Non-mydriatic · pachymetry 555 µm · centered on the optic disc · captured on a Topcon TRC-NW400 fundus camera · 2212 x 1661 pixels: 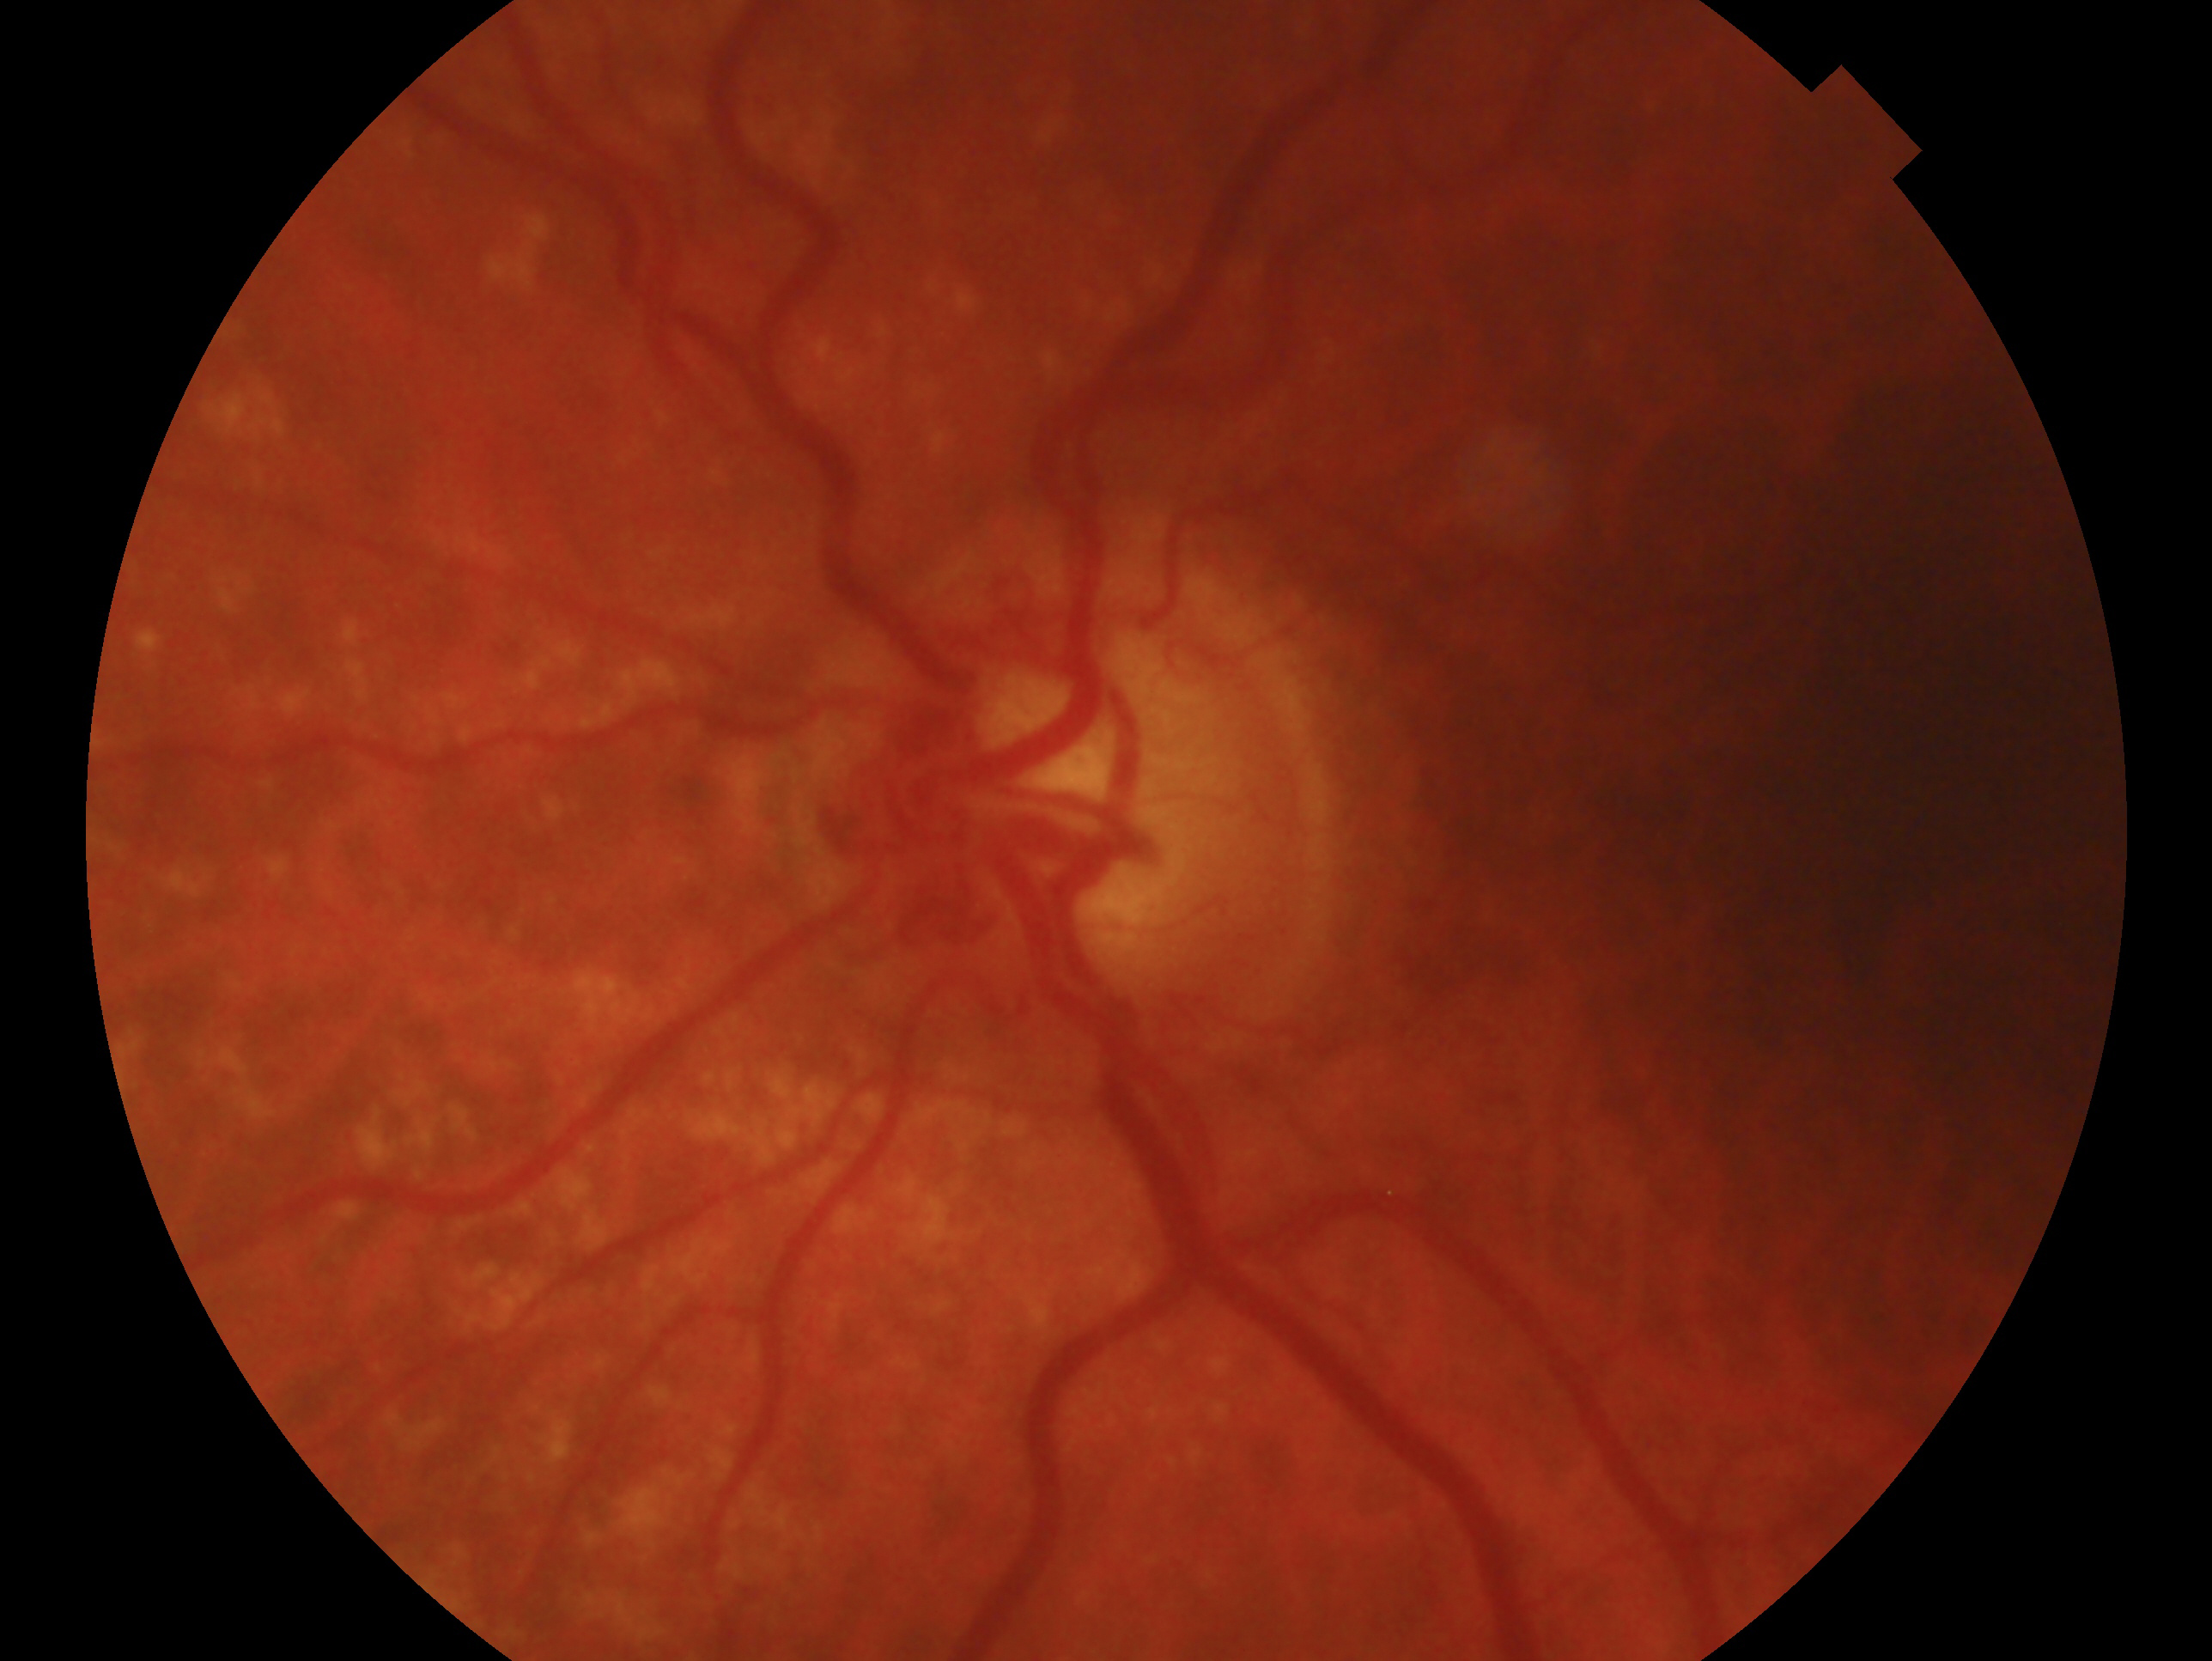

– eye · OS
– glaucoma diagnosis · consistent with glaucoma